45-degree field of view
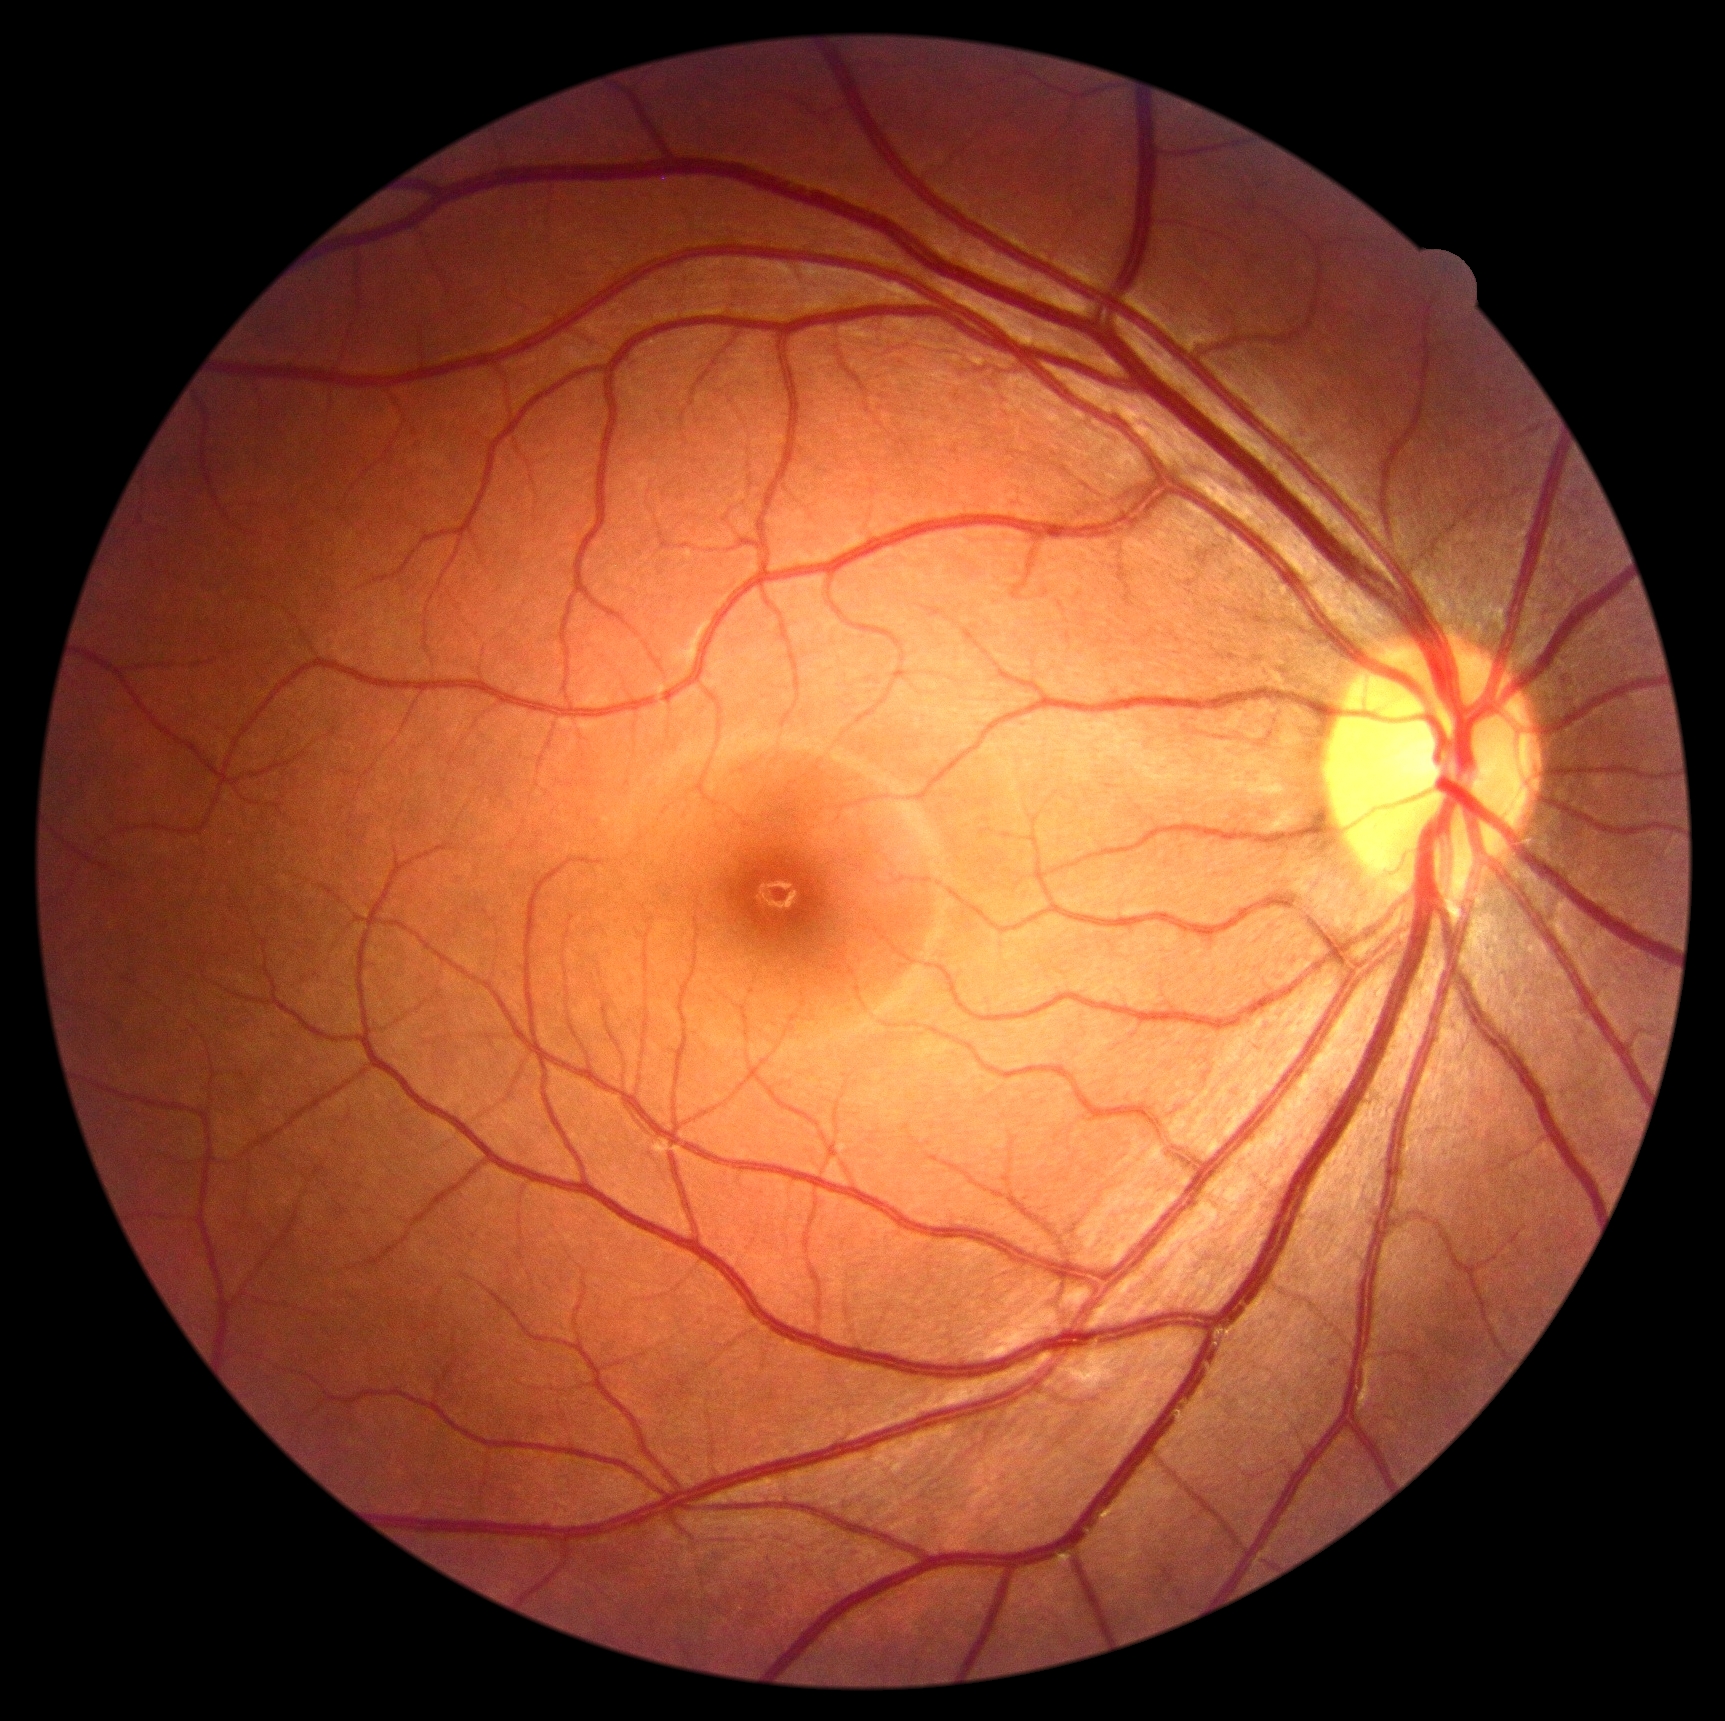

DR stage: grade 0 — no visible signs of diabetic retinopathy